Image size 848x848. Color fundus photograph. No pharmacologic dilation. 45° FOV
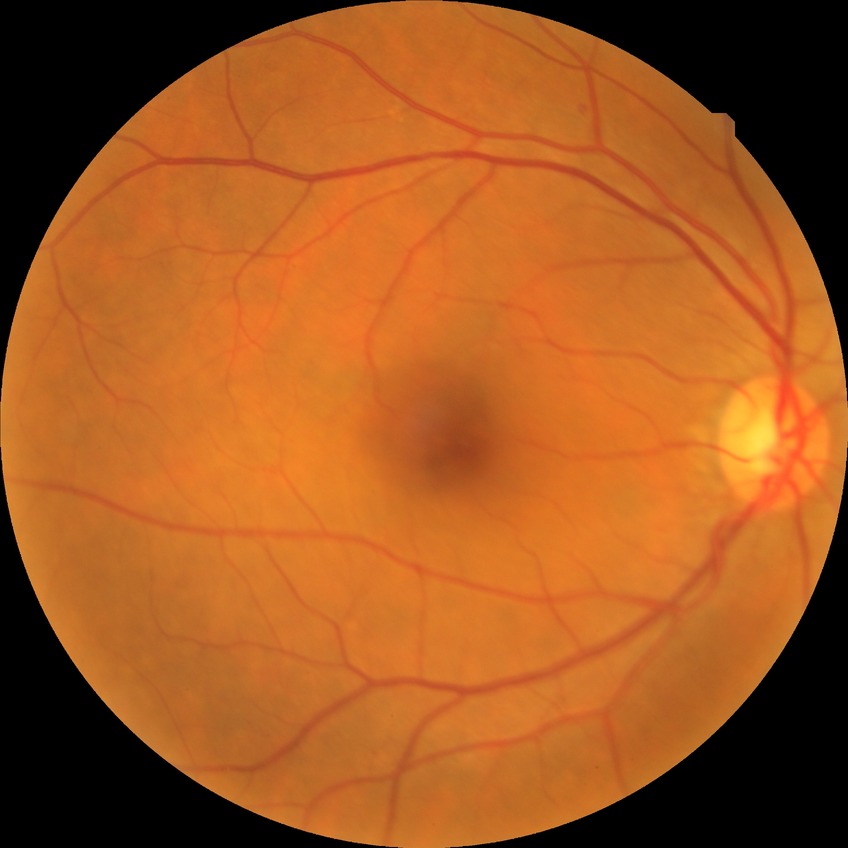
Modified Davis grading is simple diabetic retinopathy.